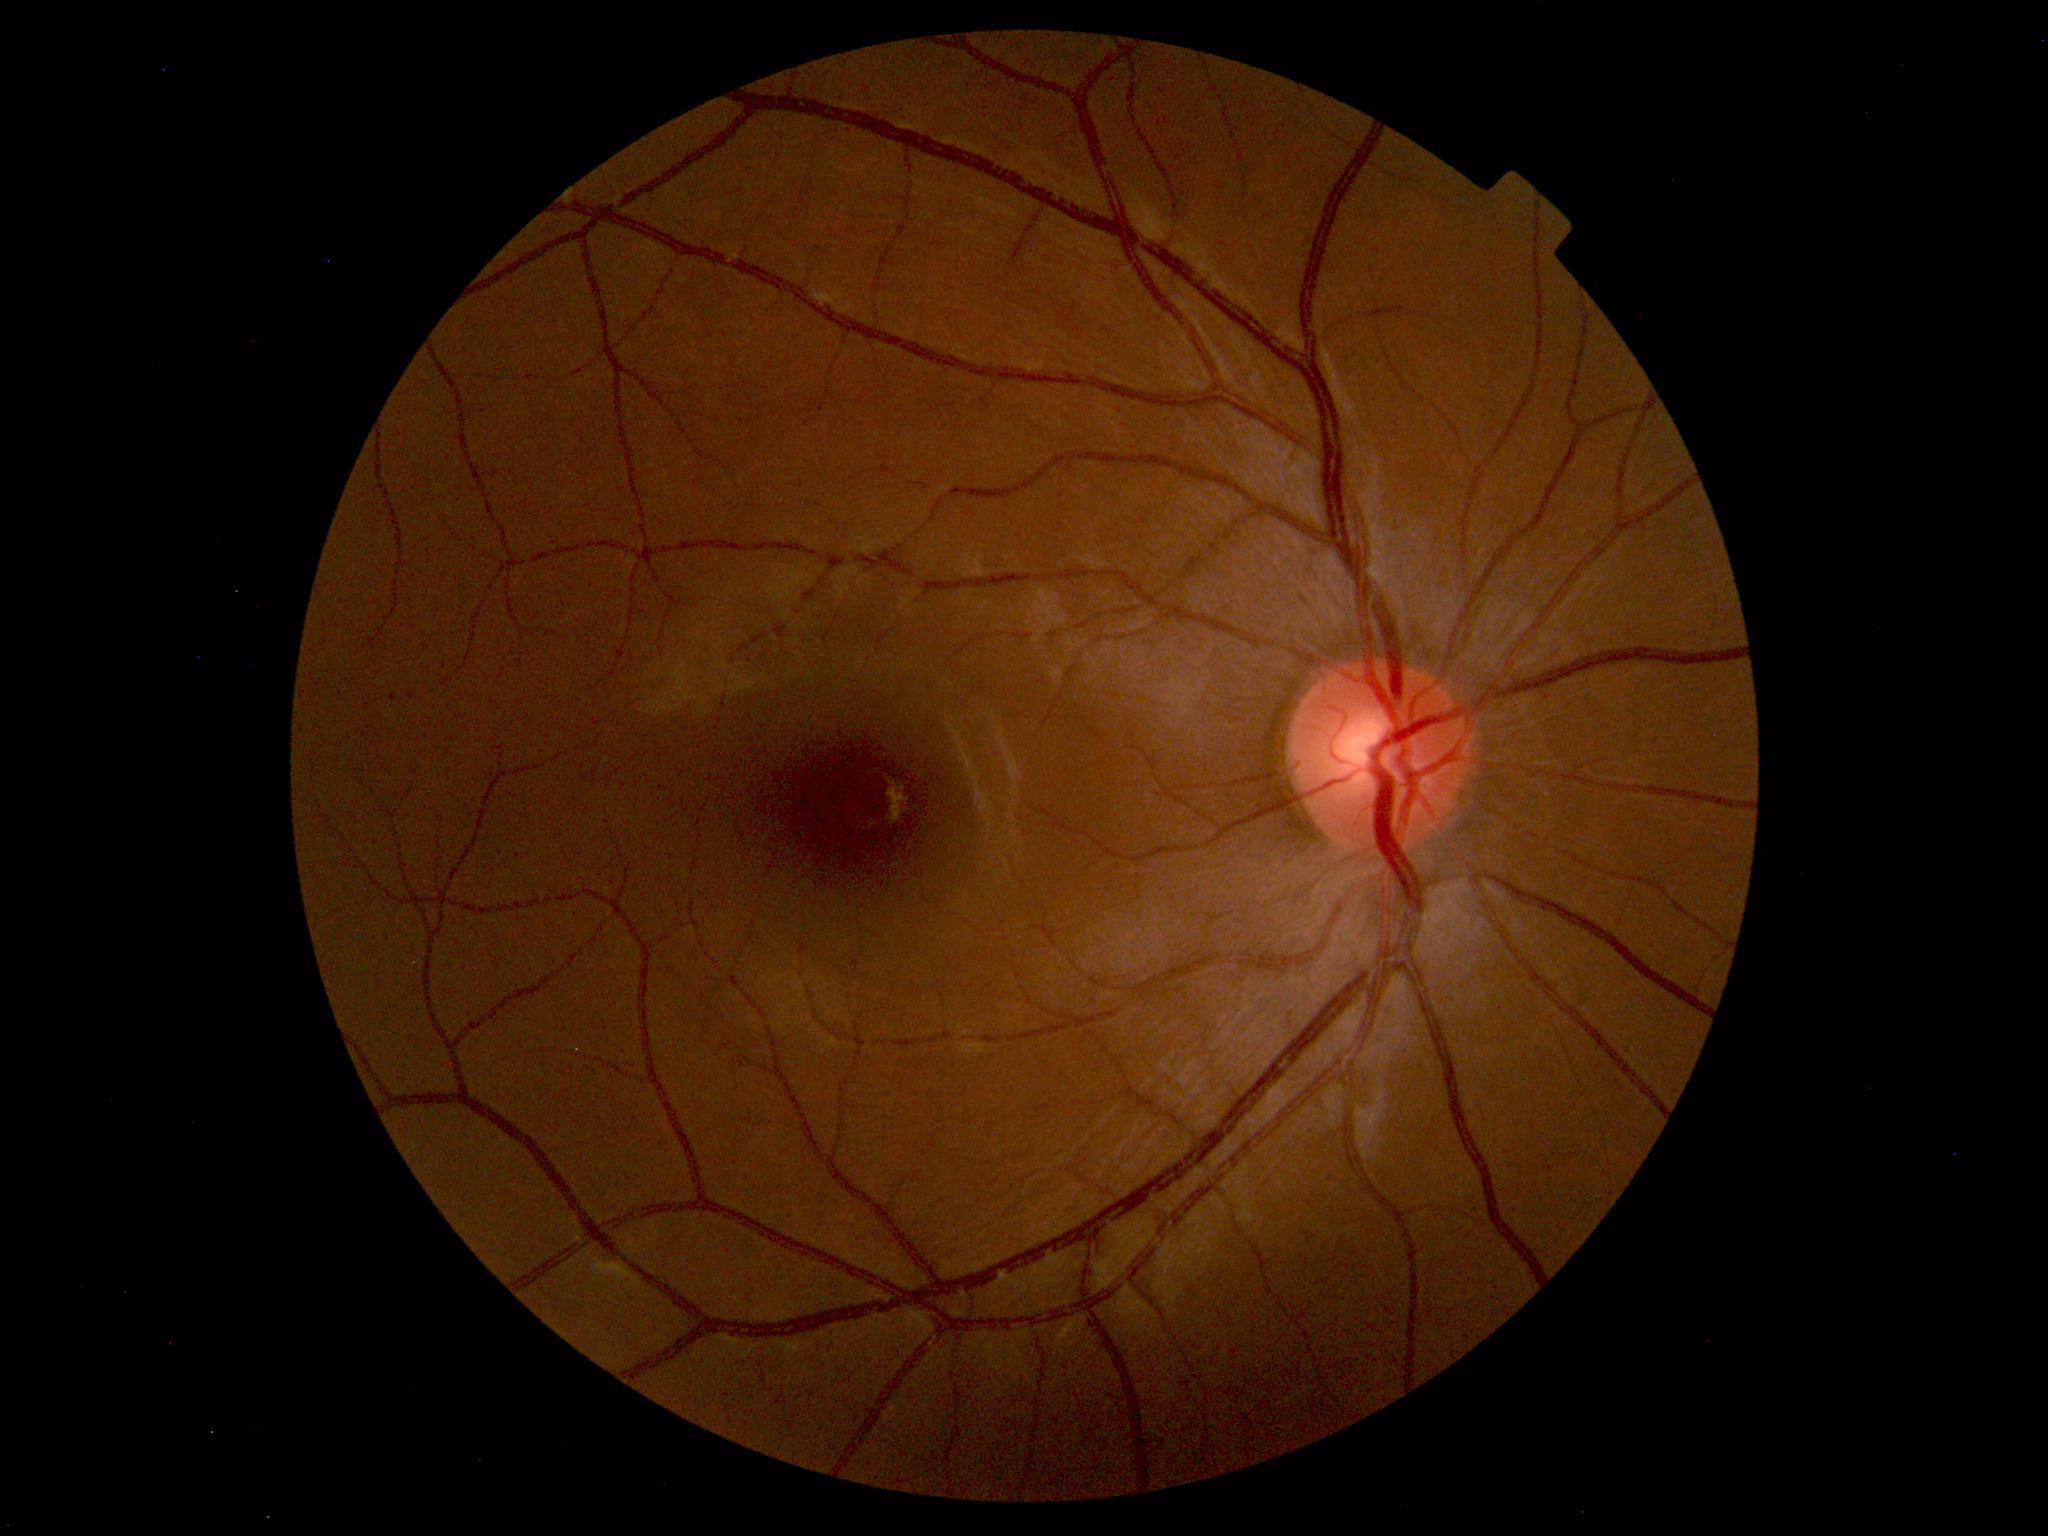 Findings: none. Normal fundus.